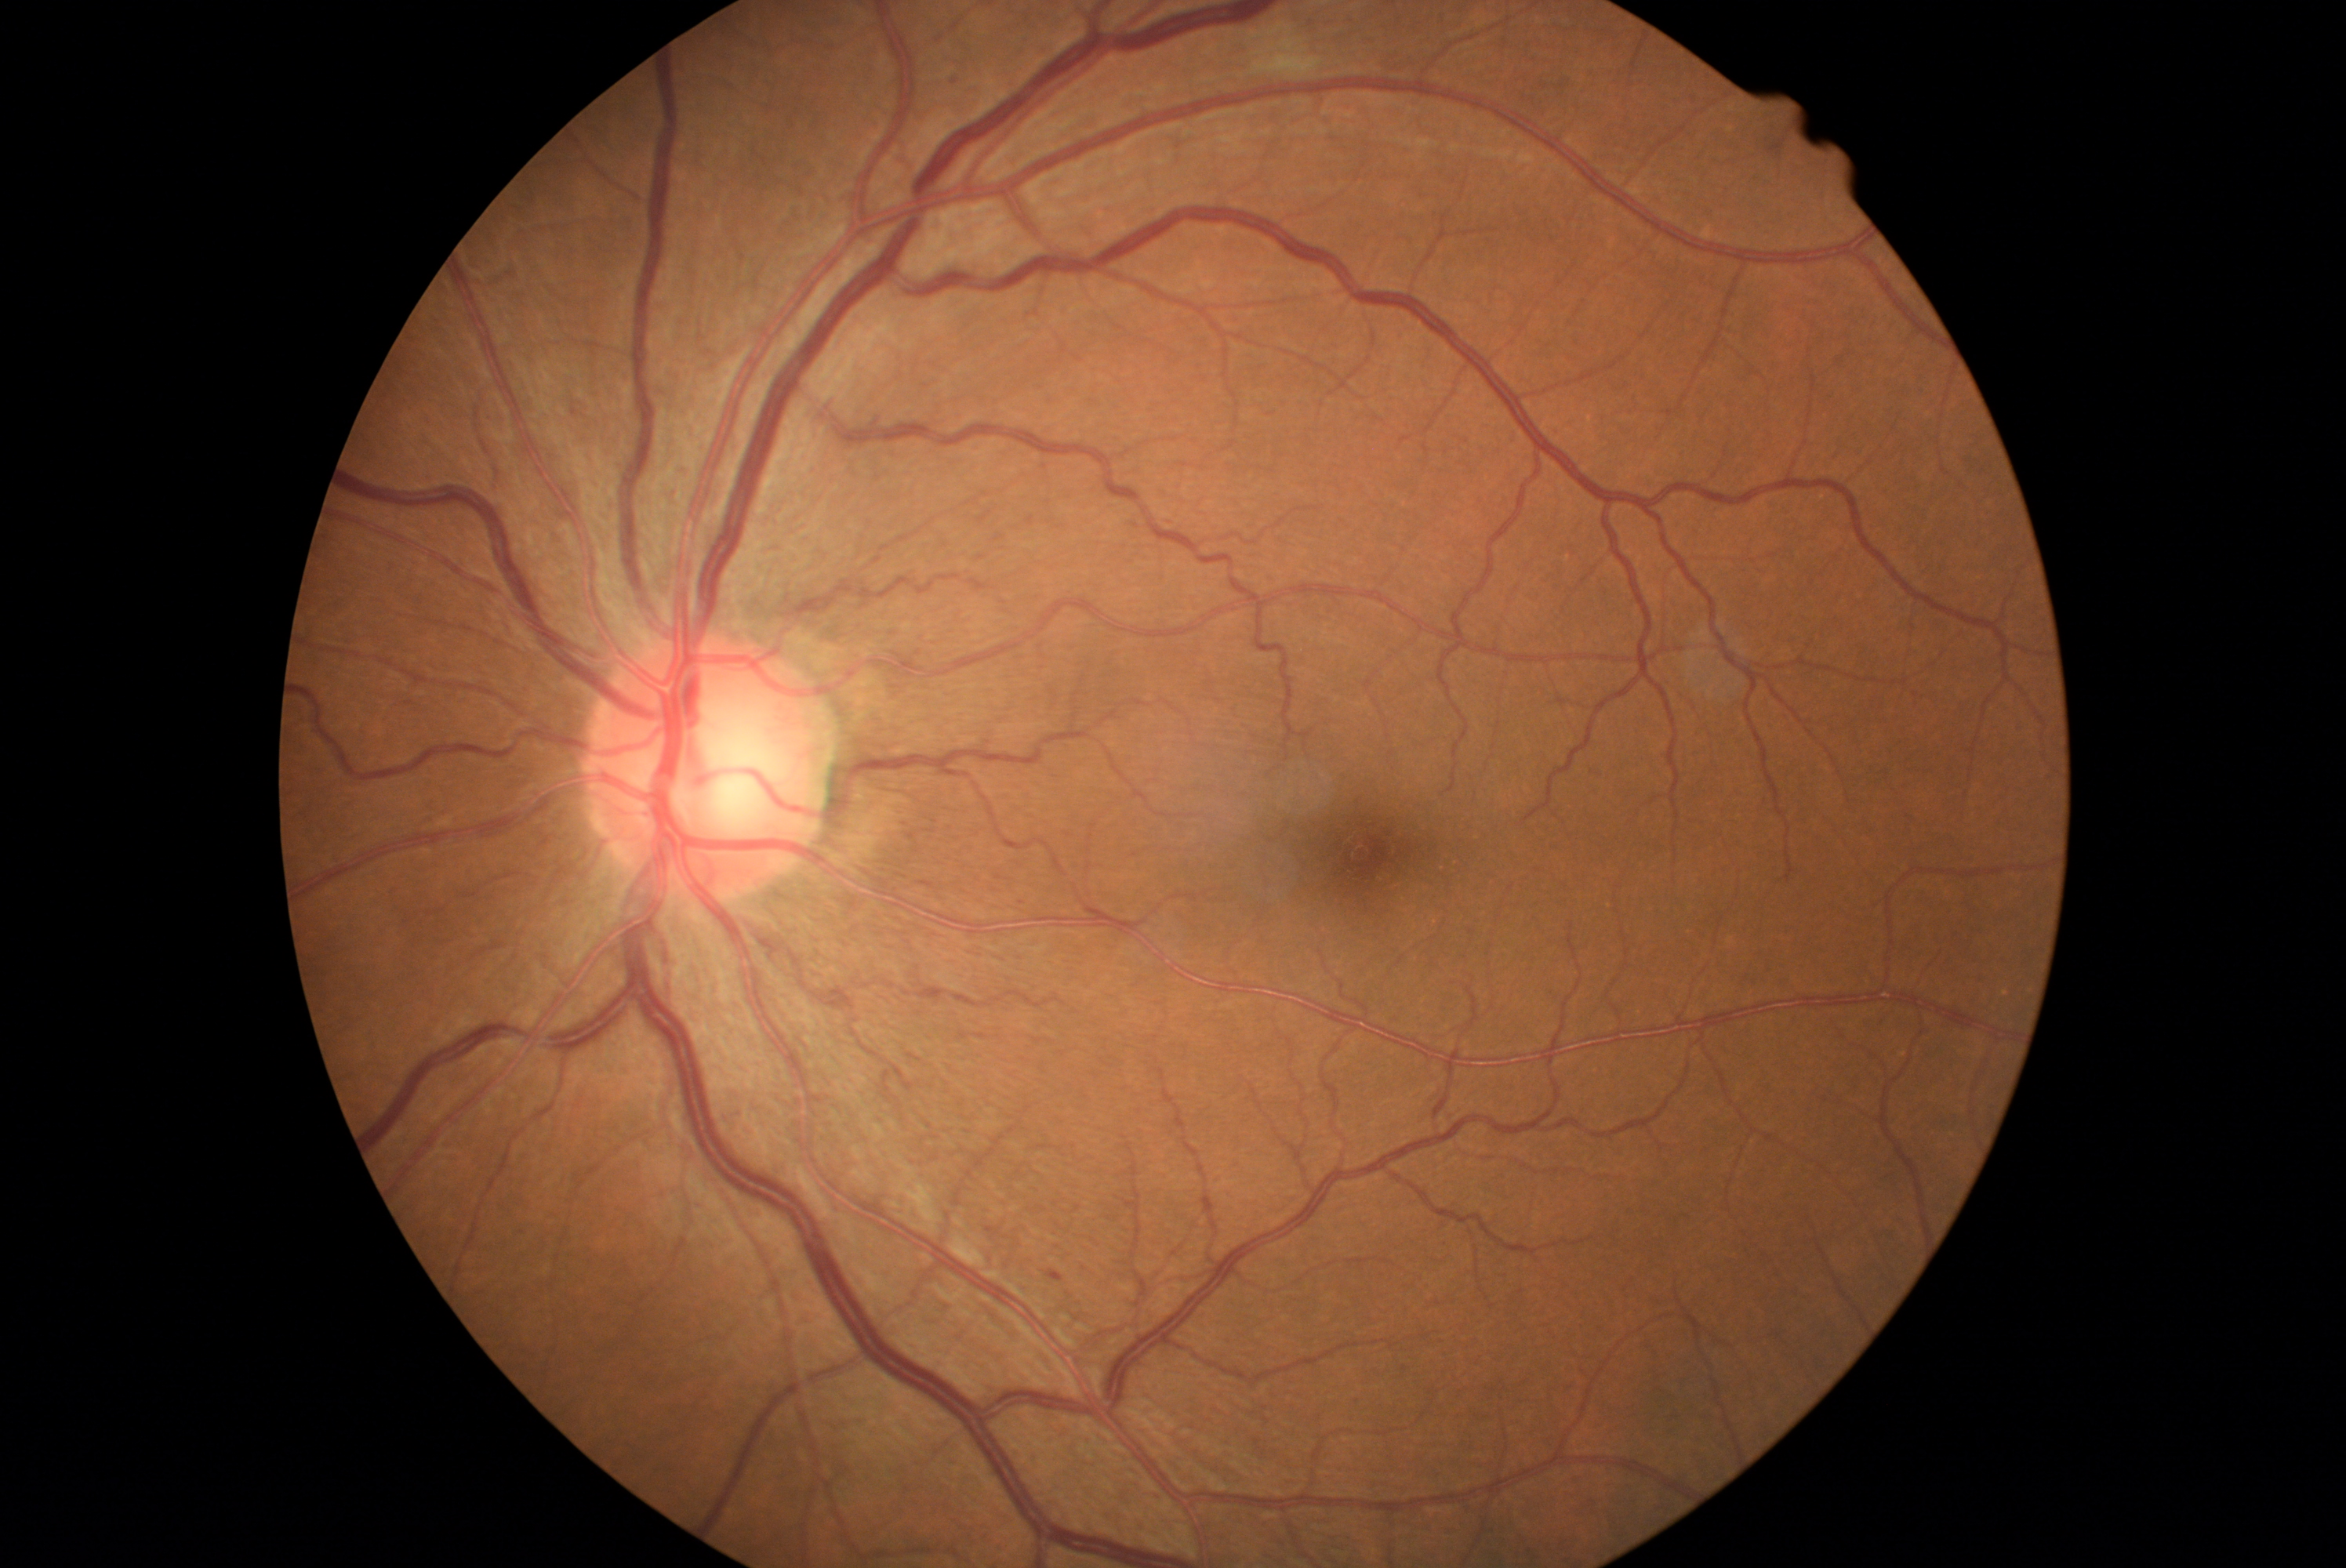

Annotations:
– retinopathy — grade 2 (moderate NPDR) — more than just microaneurysms but less than severe NPDR